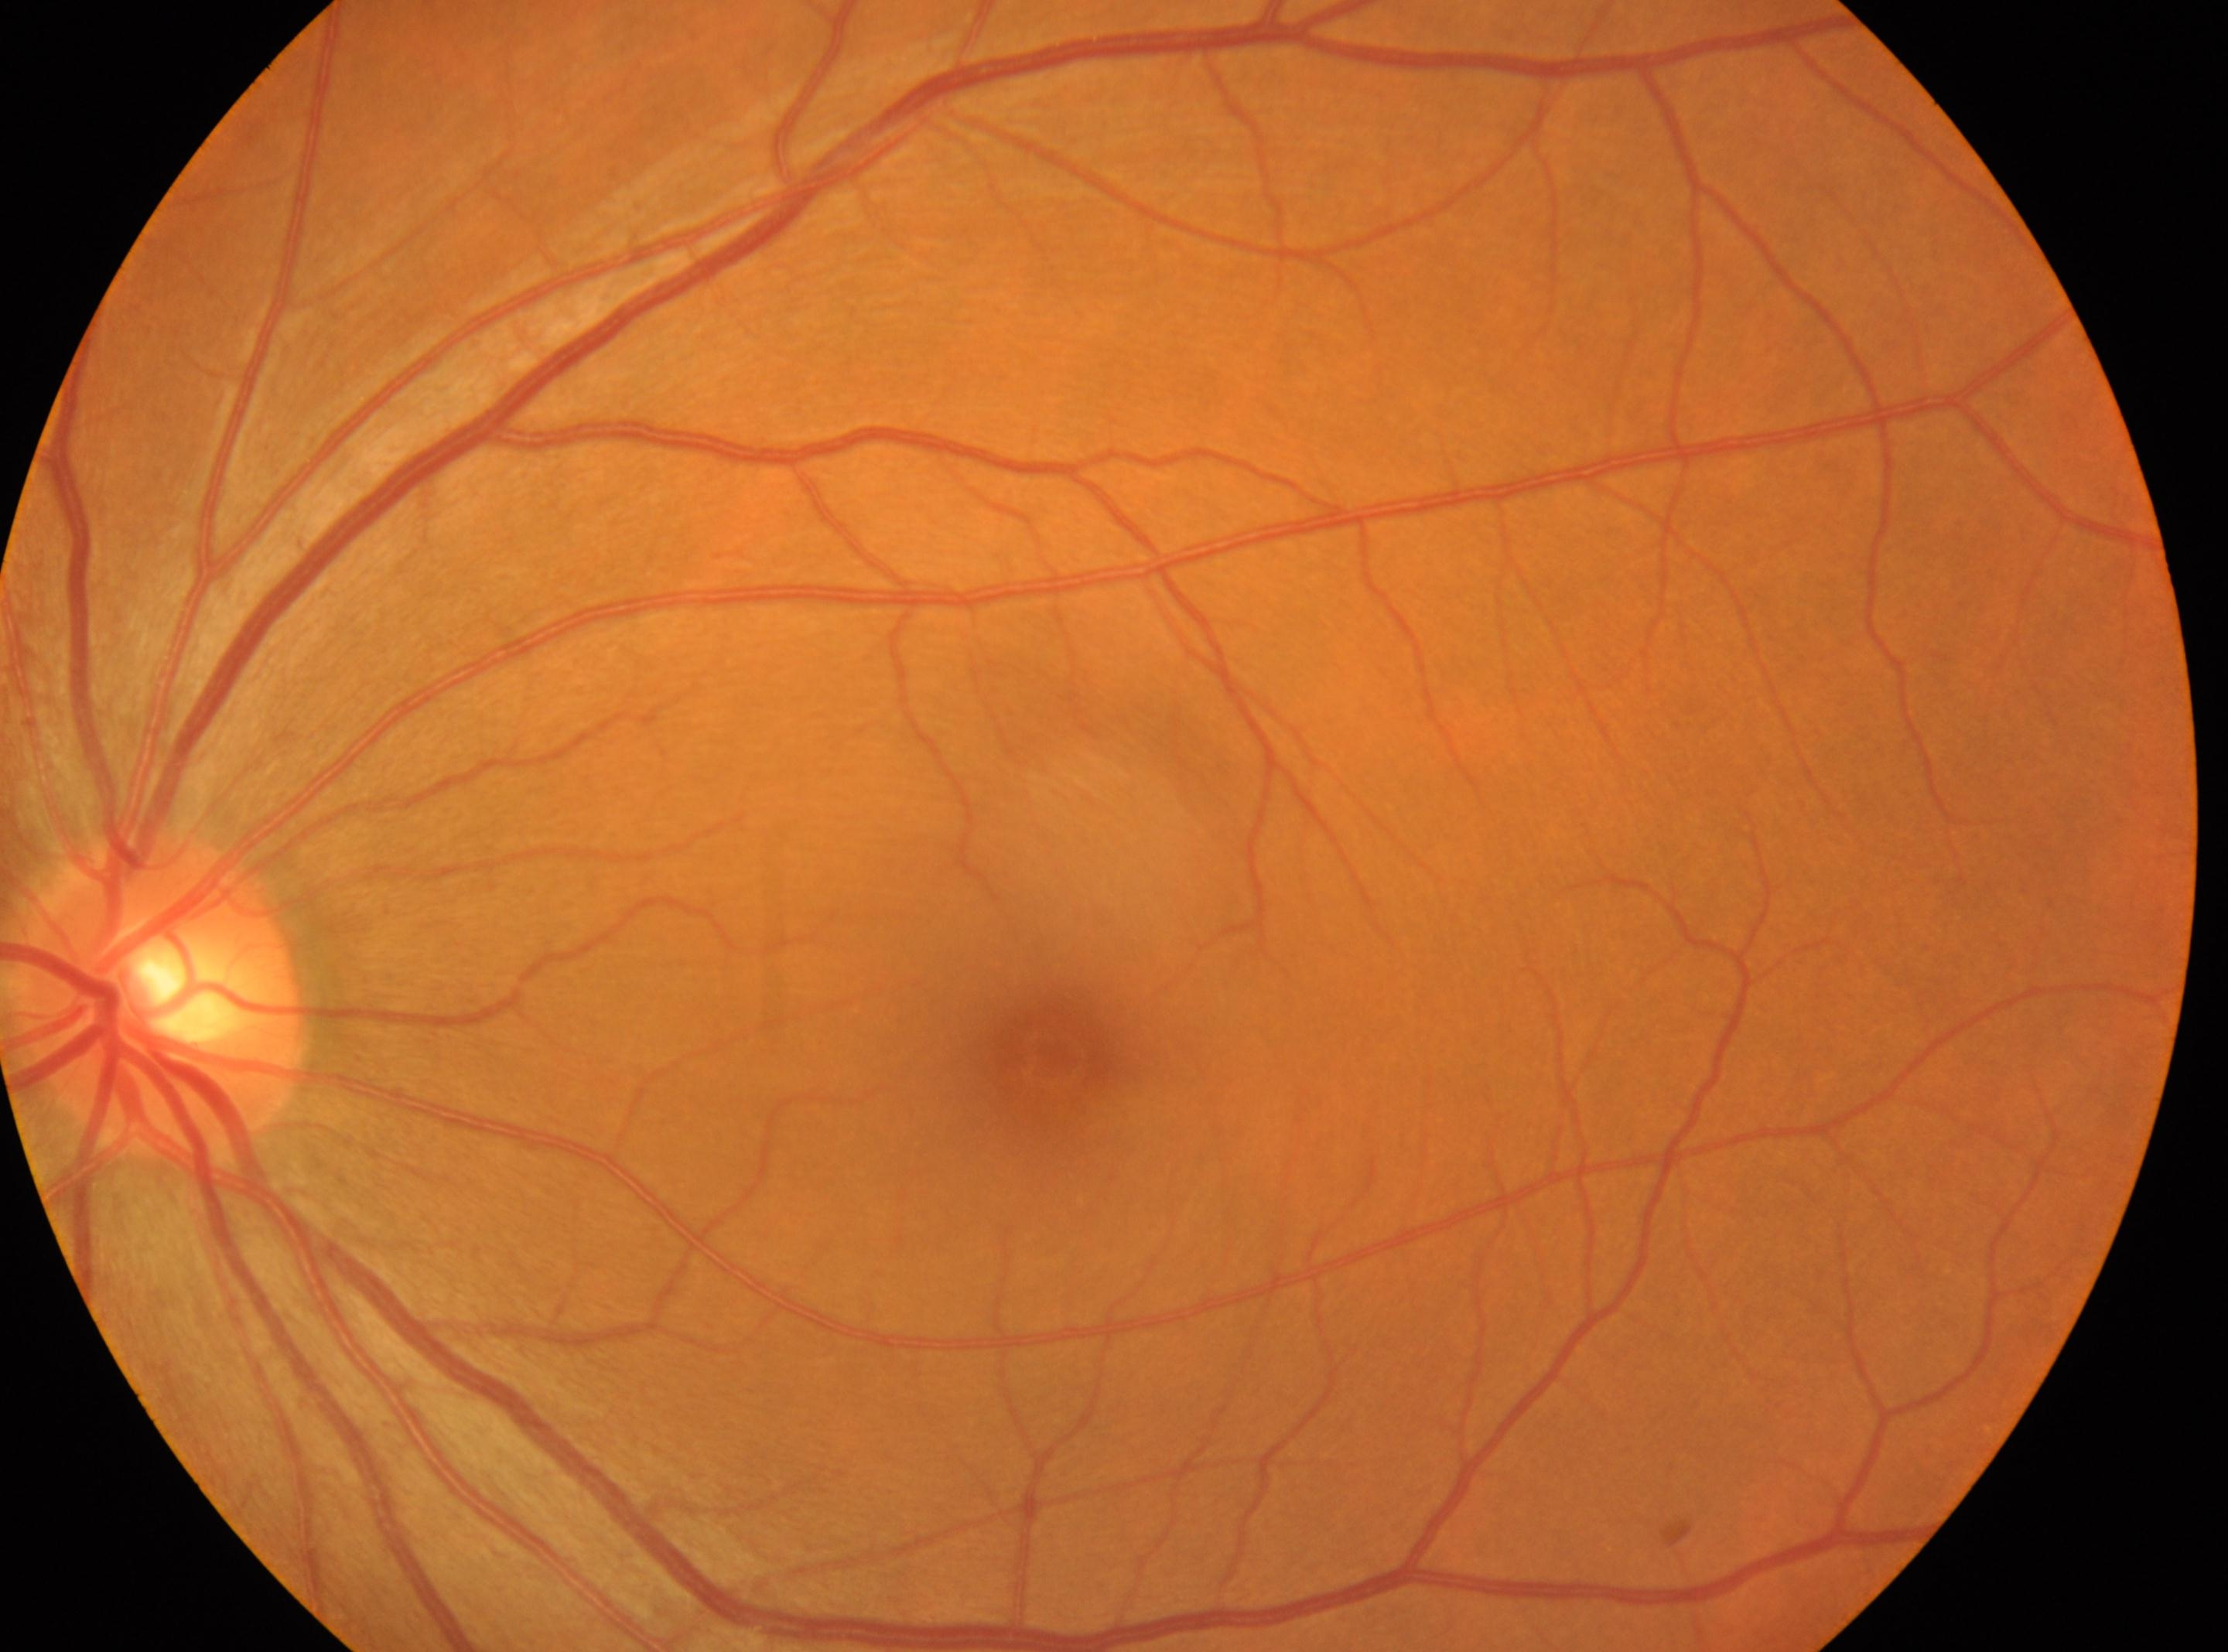
DR stage is grade 0. Imaged eye: oculus sinister. Optic disc center located at (162, 996). Foveal center: (1049, 1058).